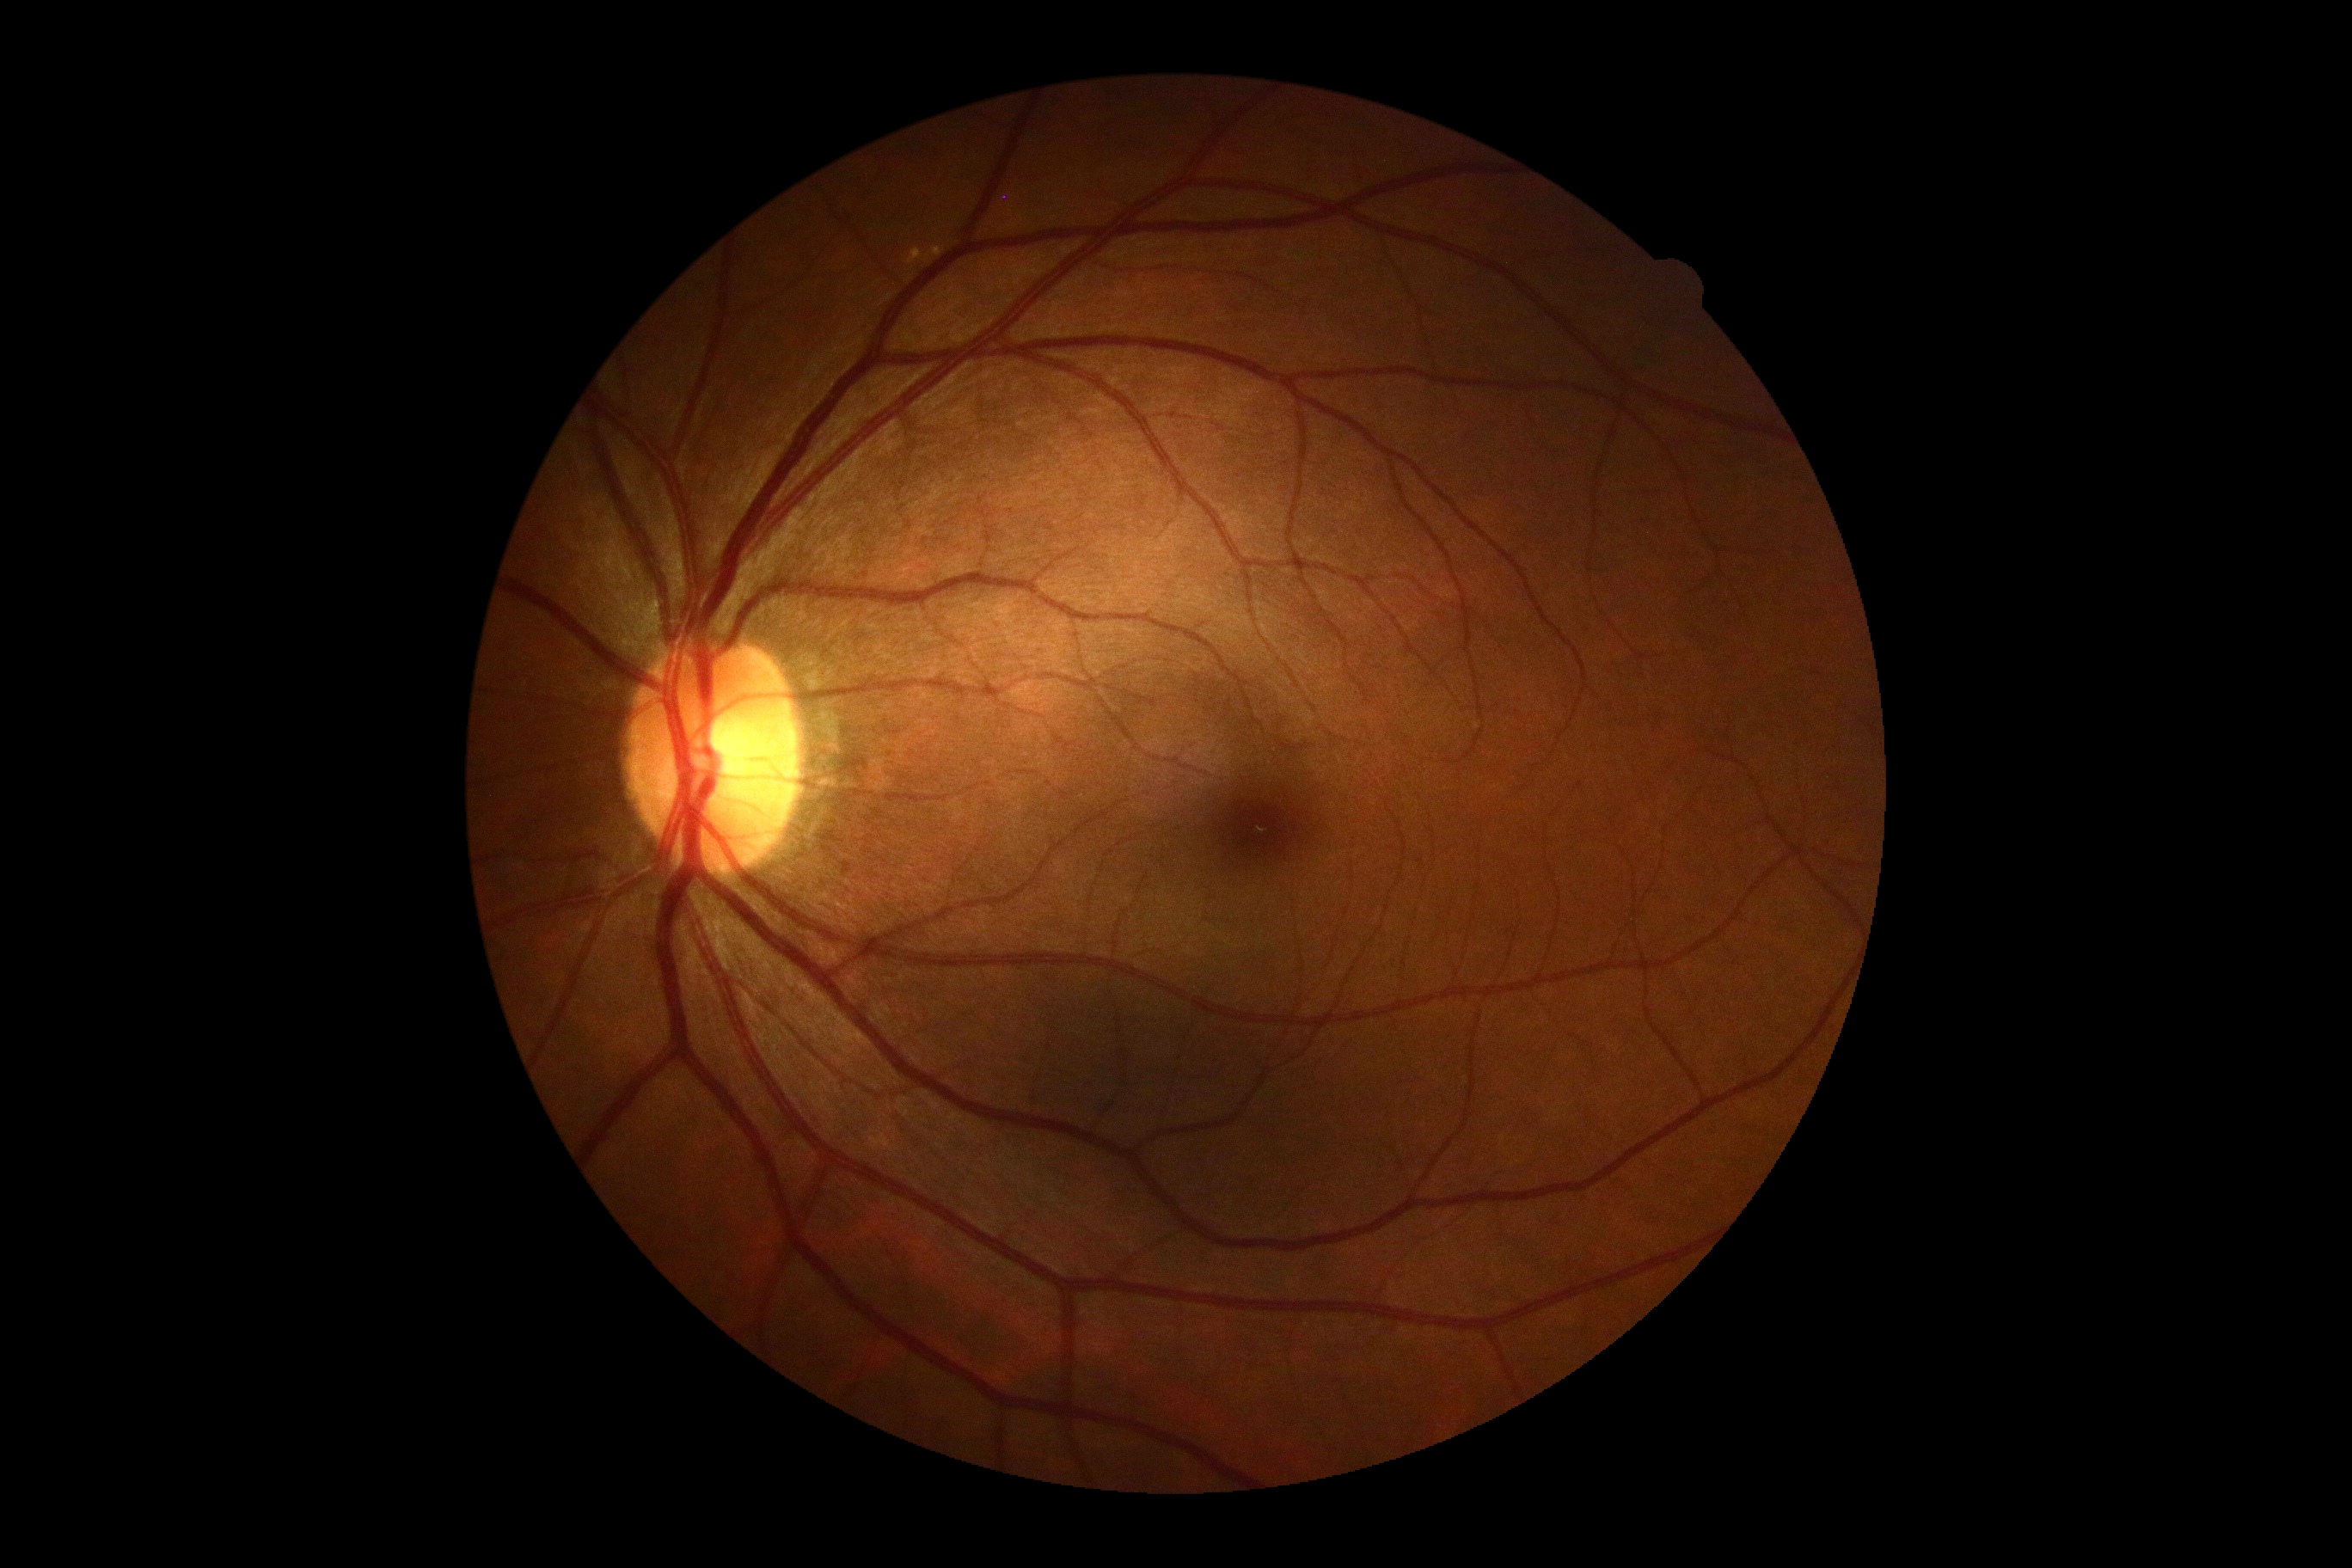

DR impression: no apparent DR, DR grade: 0.